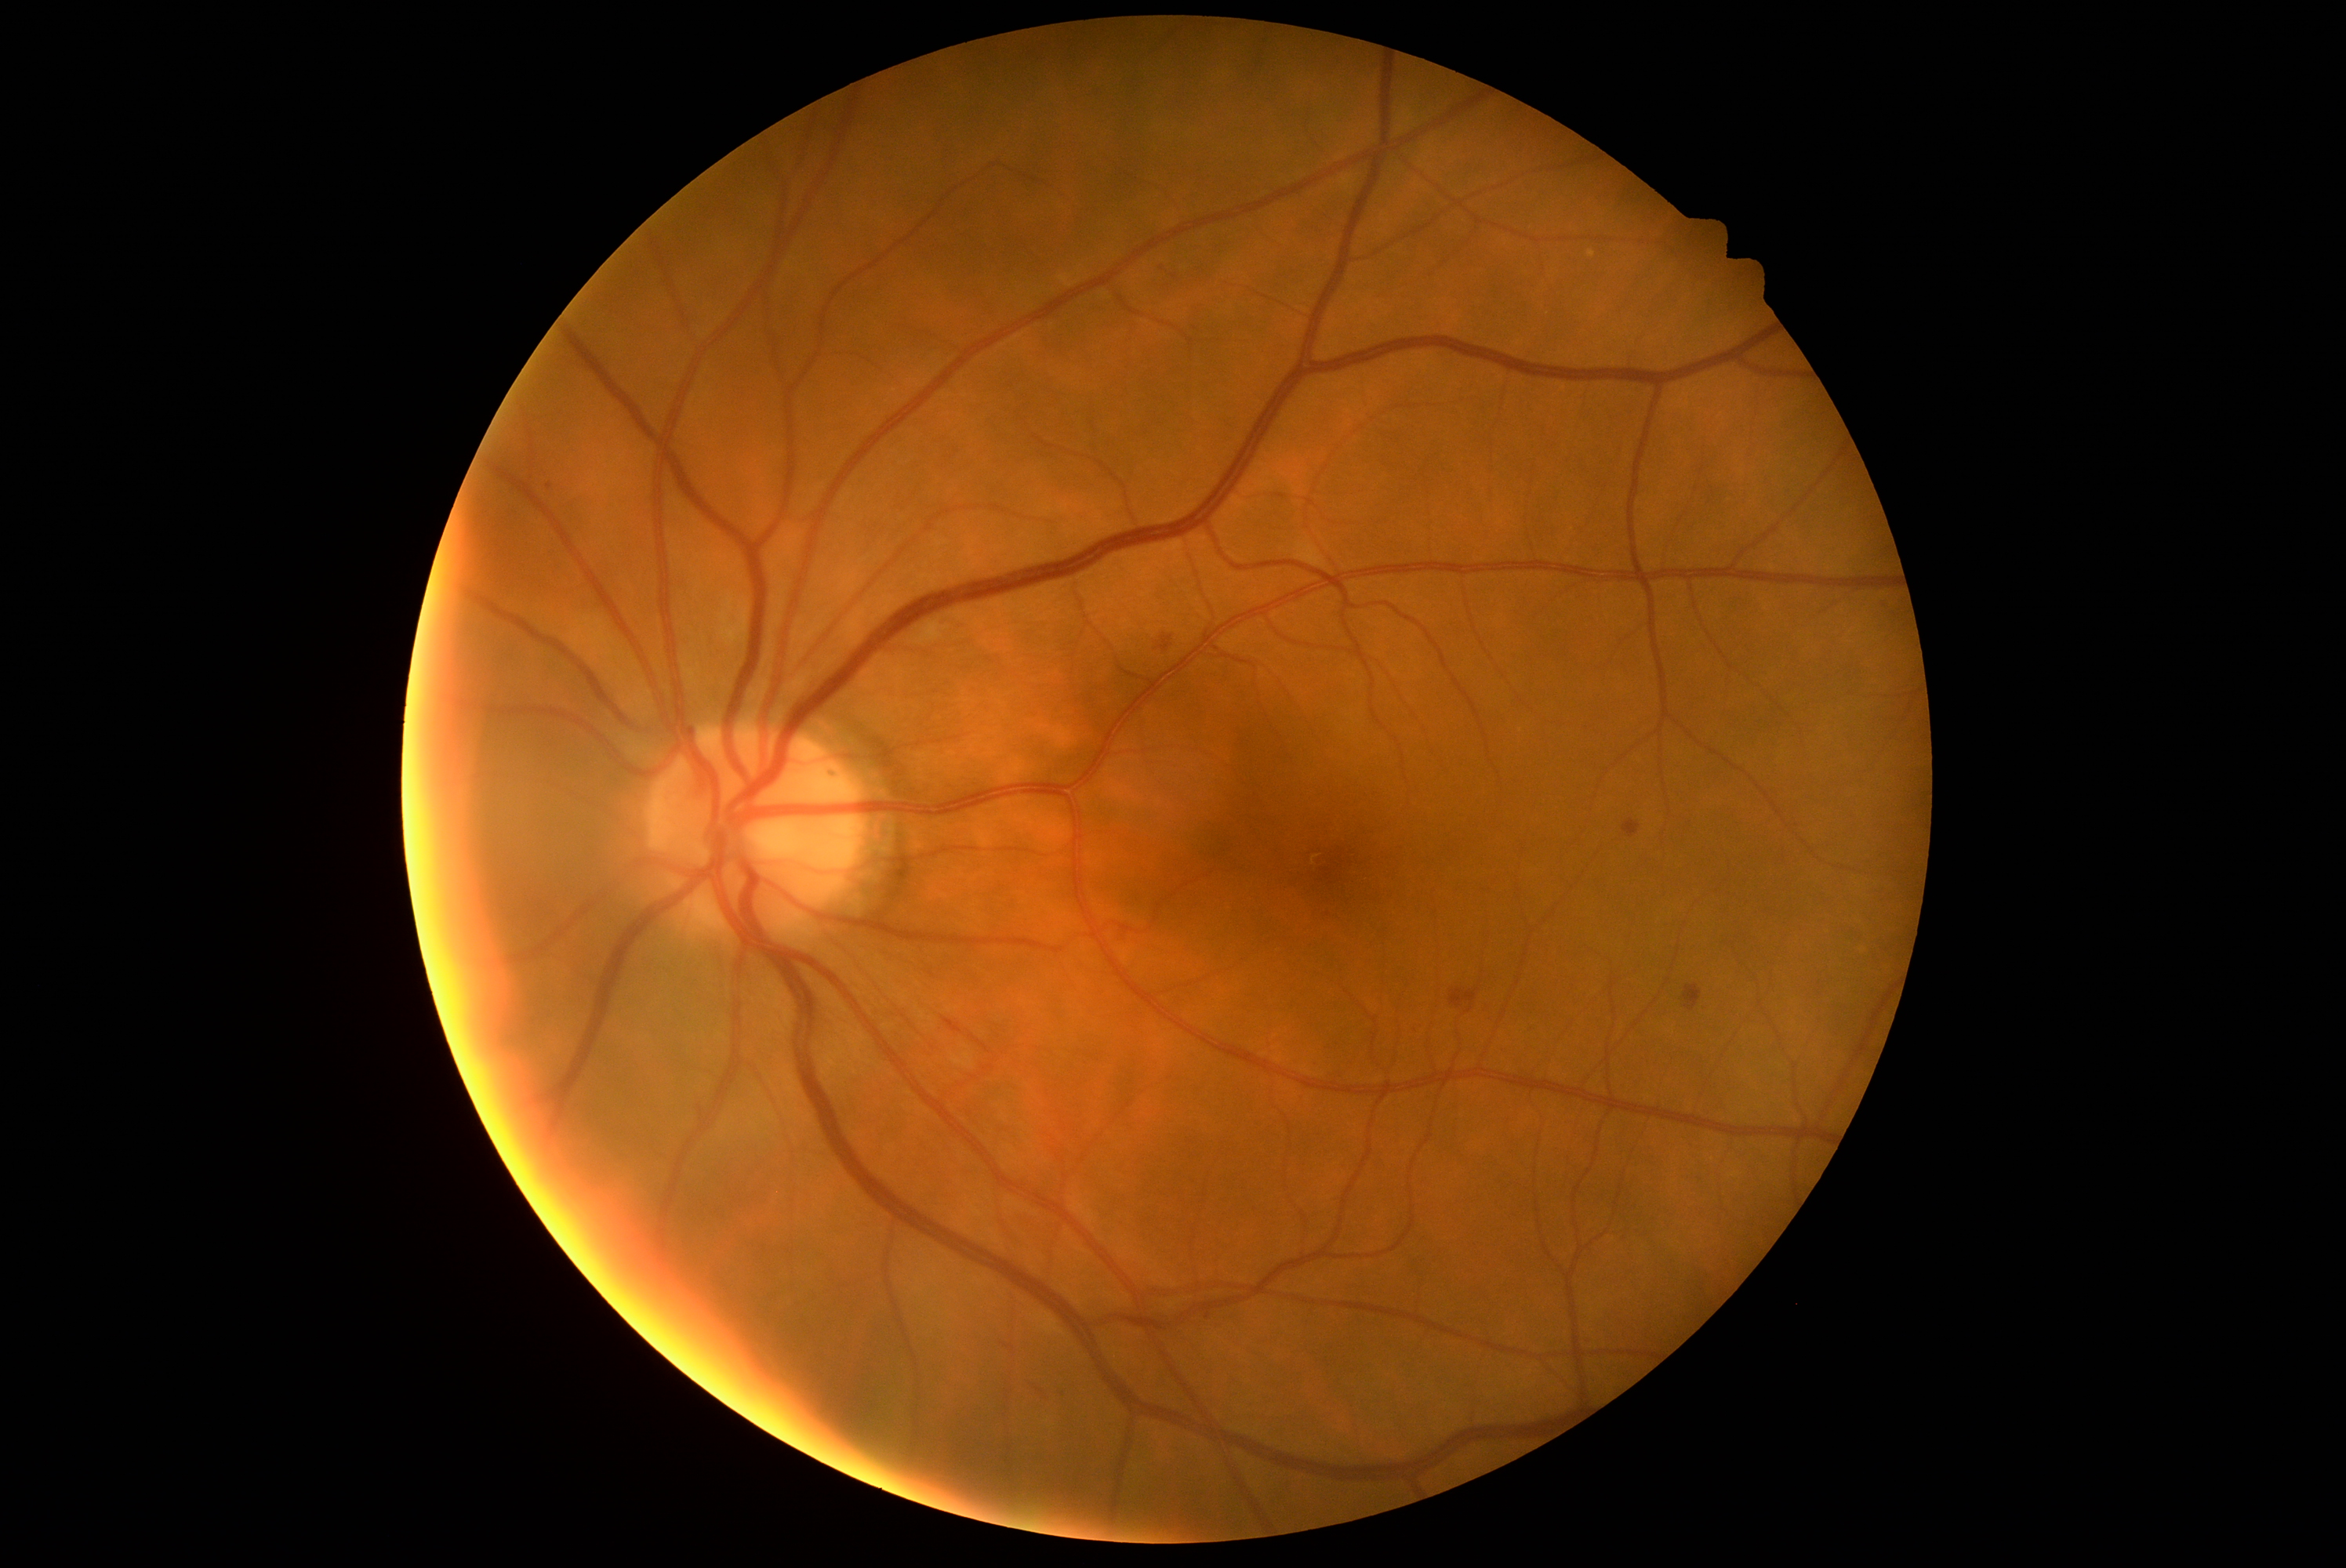

dr_grade: 2
dr_grade_name: moderate NPDR
lesions:
  ex: []
  ma:
    - BBox(1202, 1305, 1210, 1316)
  ma_small_centers:
    - (x=549, y=487)
  he:
    - BBox(1026, 1376, 1044, 1395)
    - BBox(1685, 985, 1702, 1012)
    - BBox(699, 1106, 713, 1131)
    - BBox(1622, 819, 1641, 838)
    - BBox(1451, 990, 1480, 1014)
    - BBox(1158, 634, 1174, 653)
    - BBox(943, 1018, 964, 1034)
    - BBox(970, 1036, 990, 1054)
  se: []